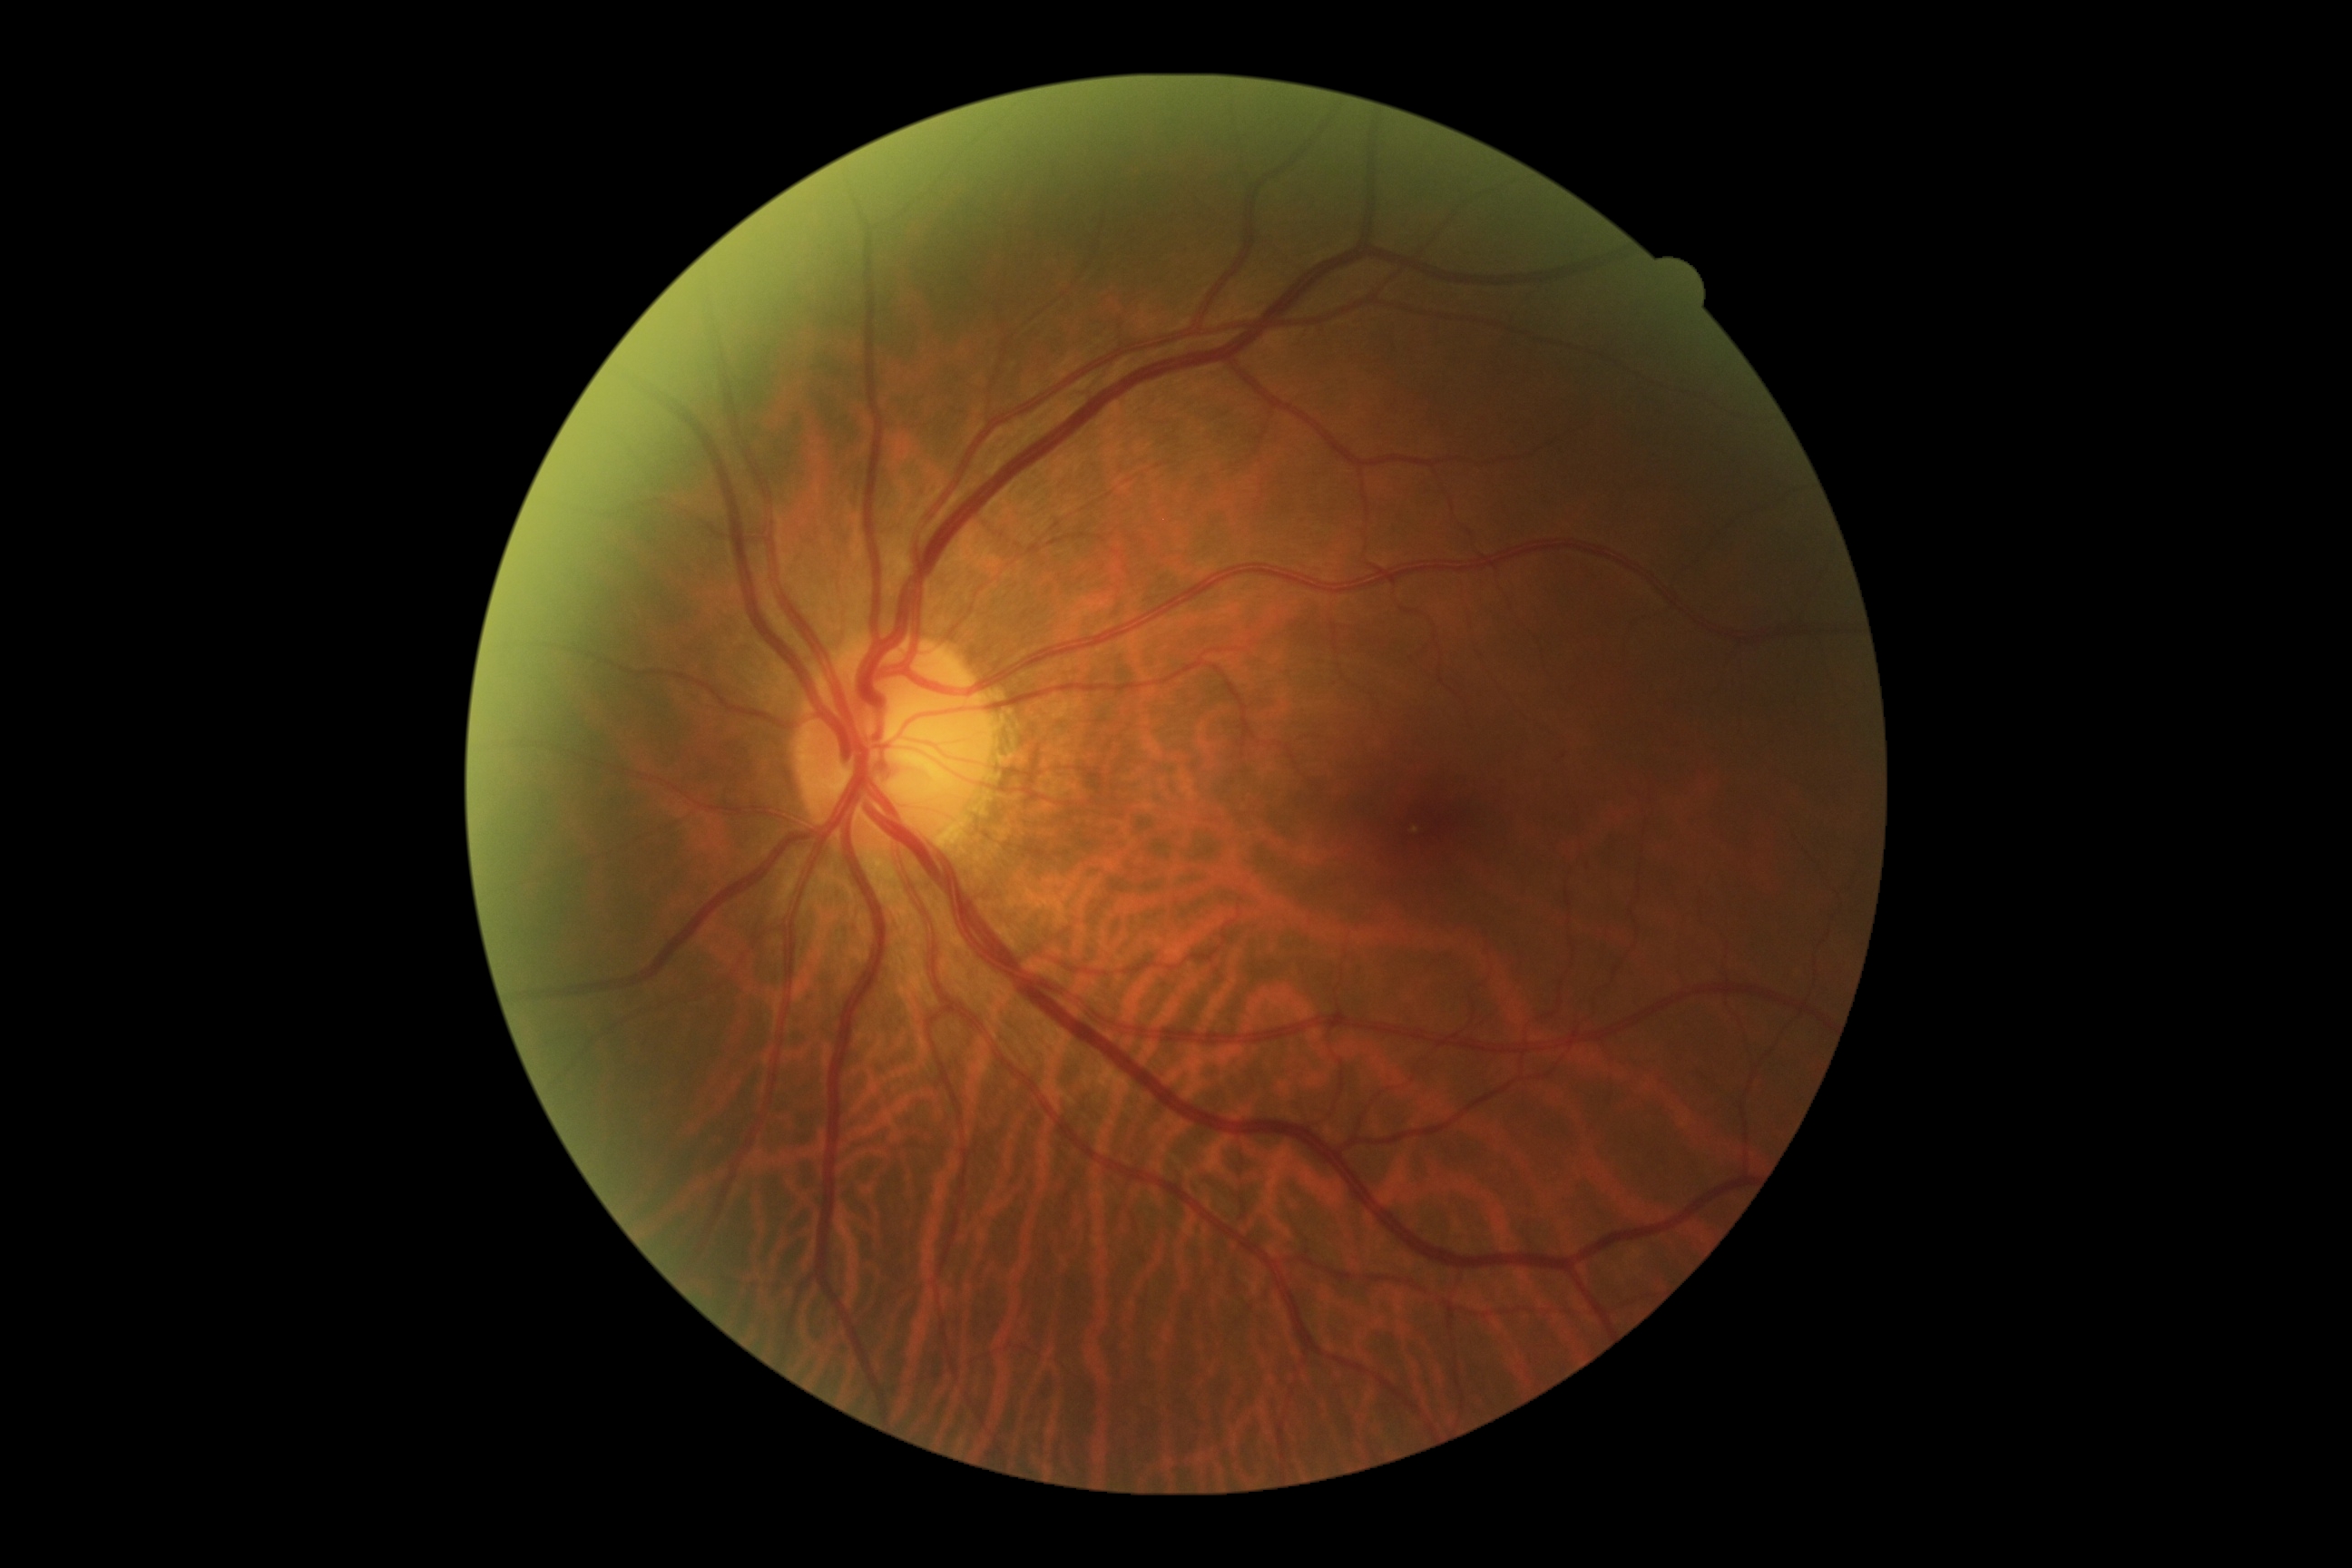
dr_grade: 0 (no apparent retinopathy)